Optic disc-centered crop from a color fundus photograph: 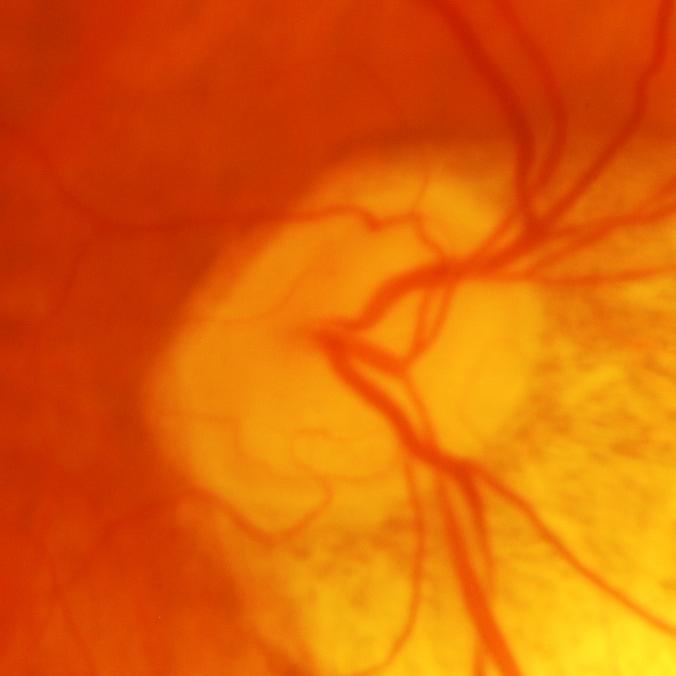

Showing glaucoma.